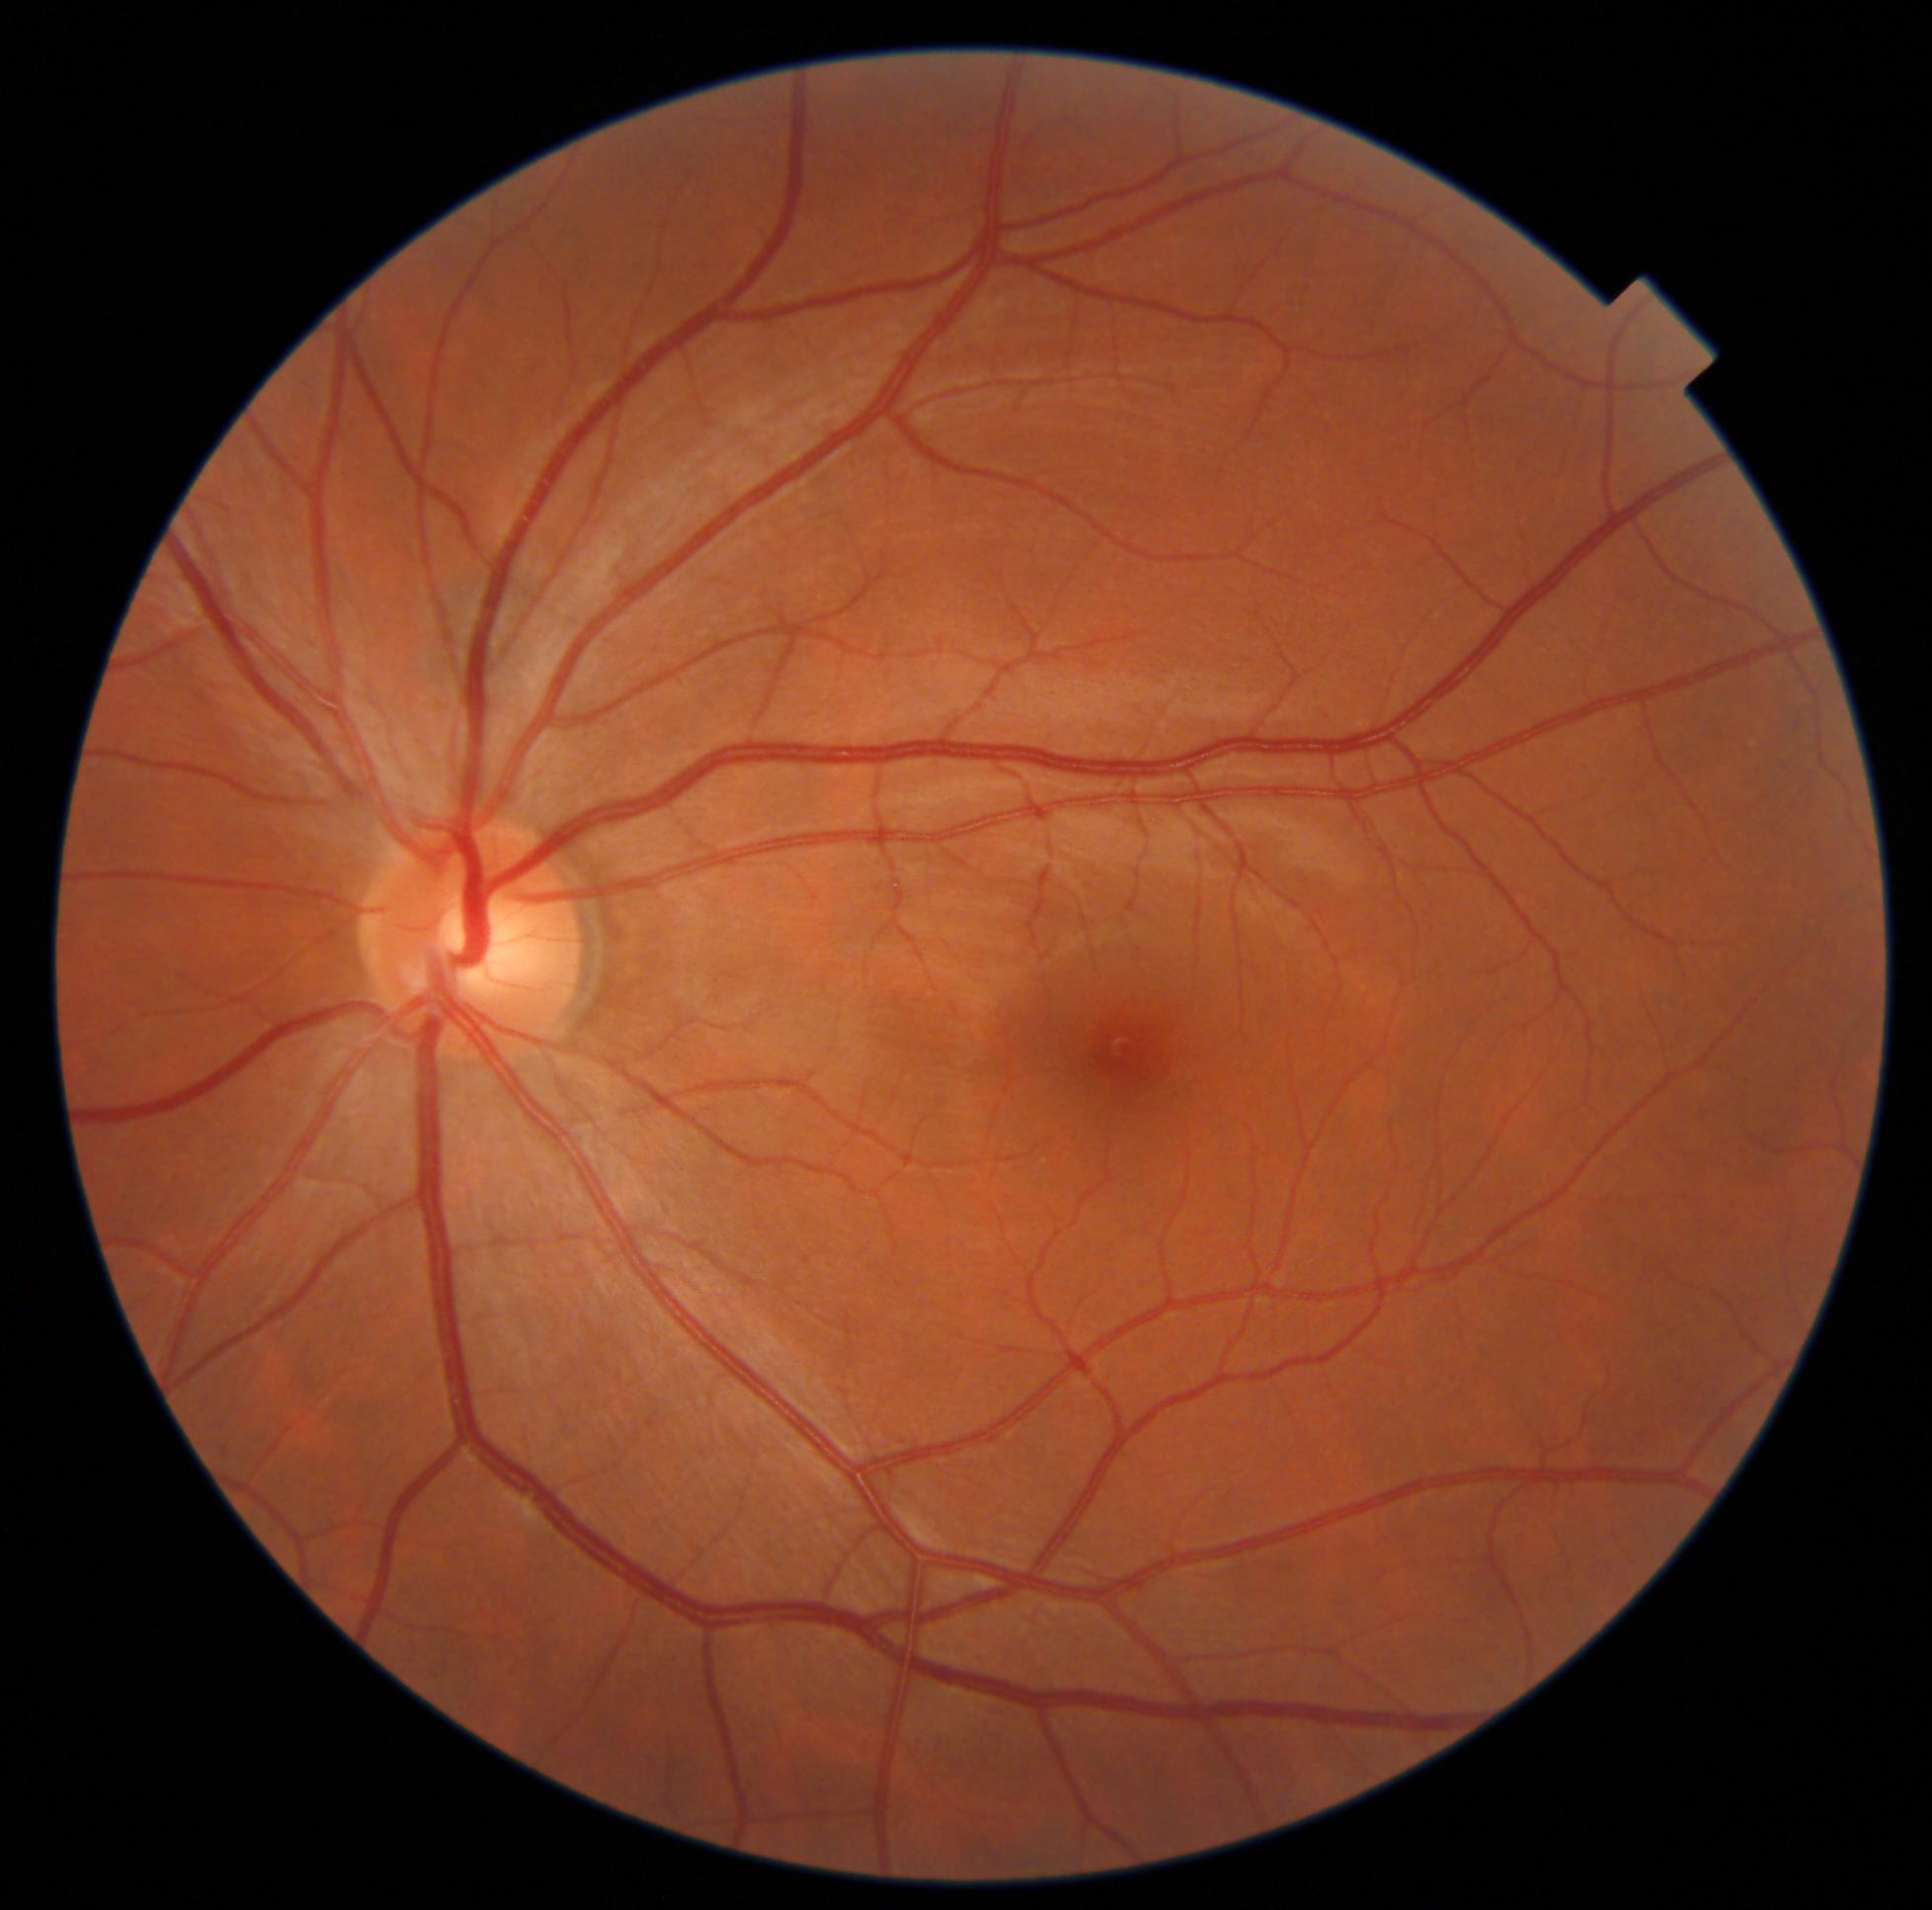
DR grade is no apparent diabetic retinopathy (0).